2212x1659 — 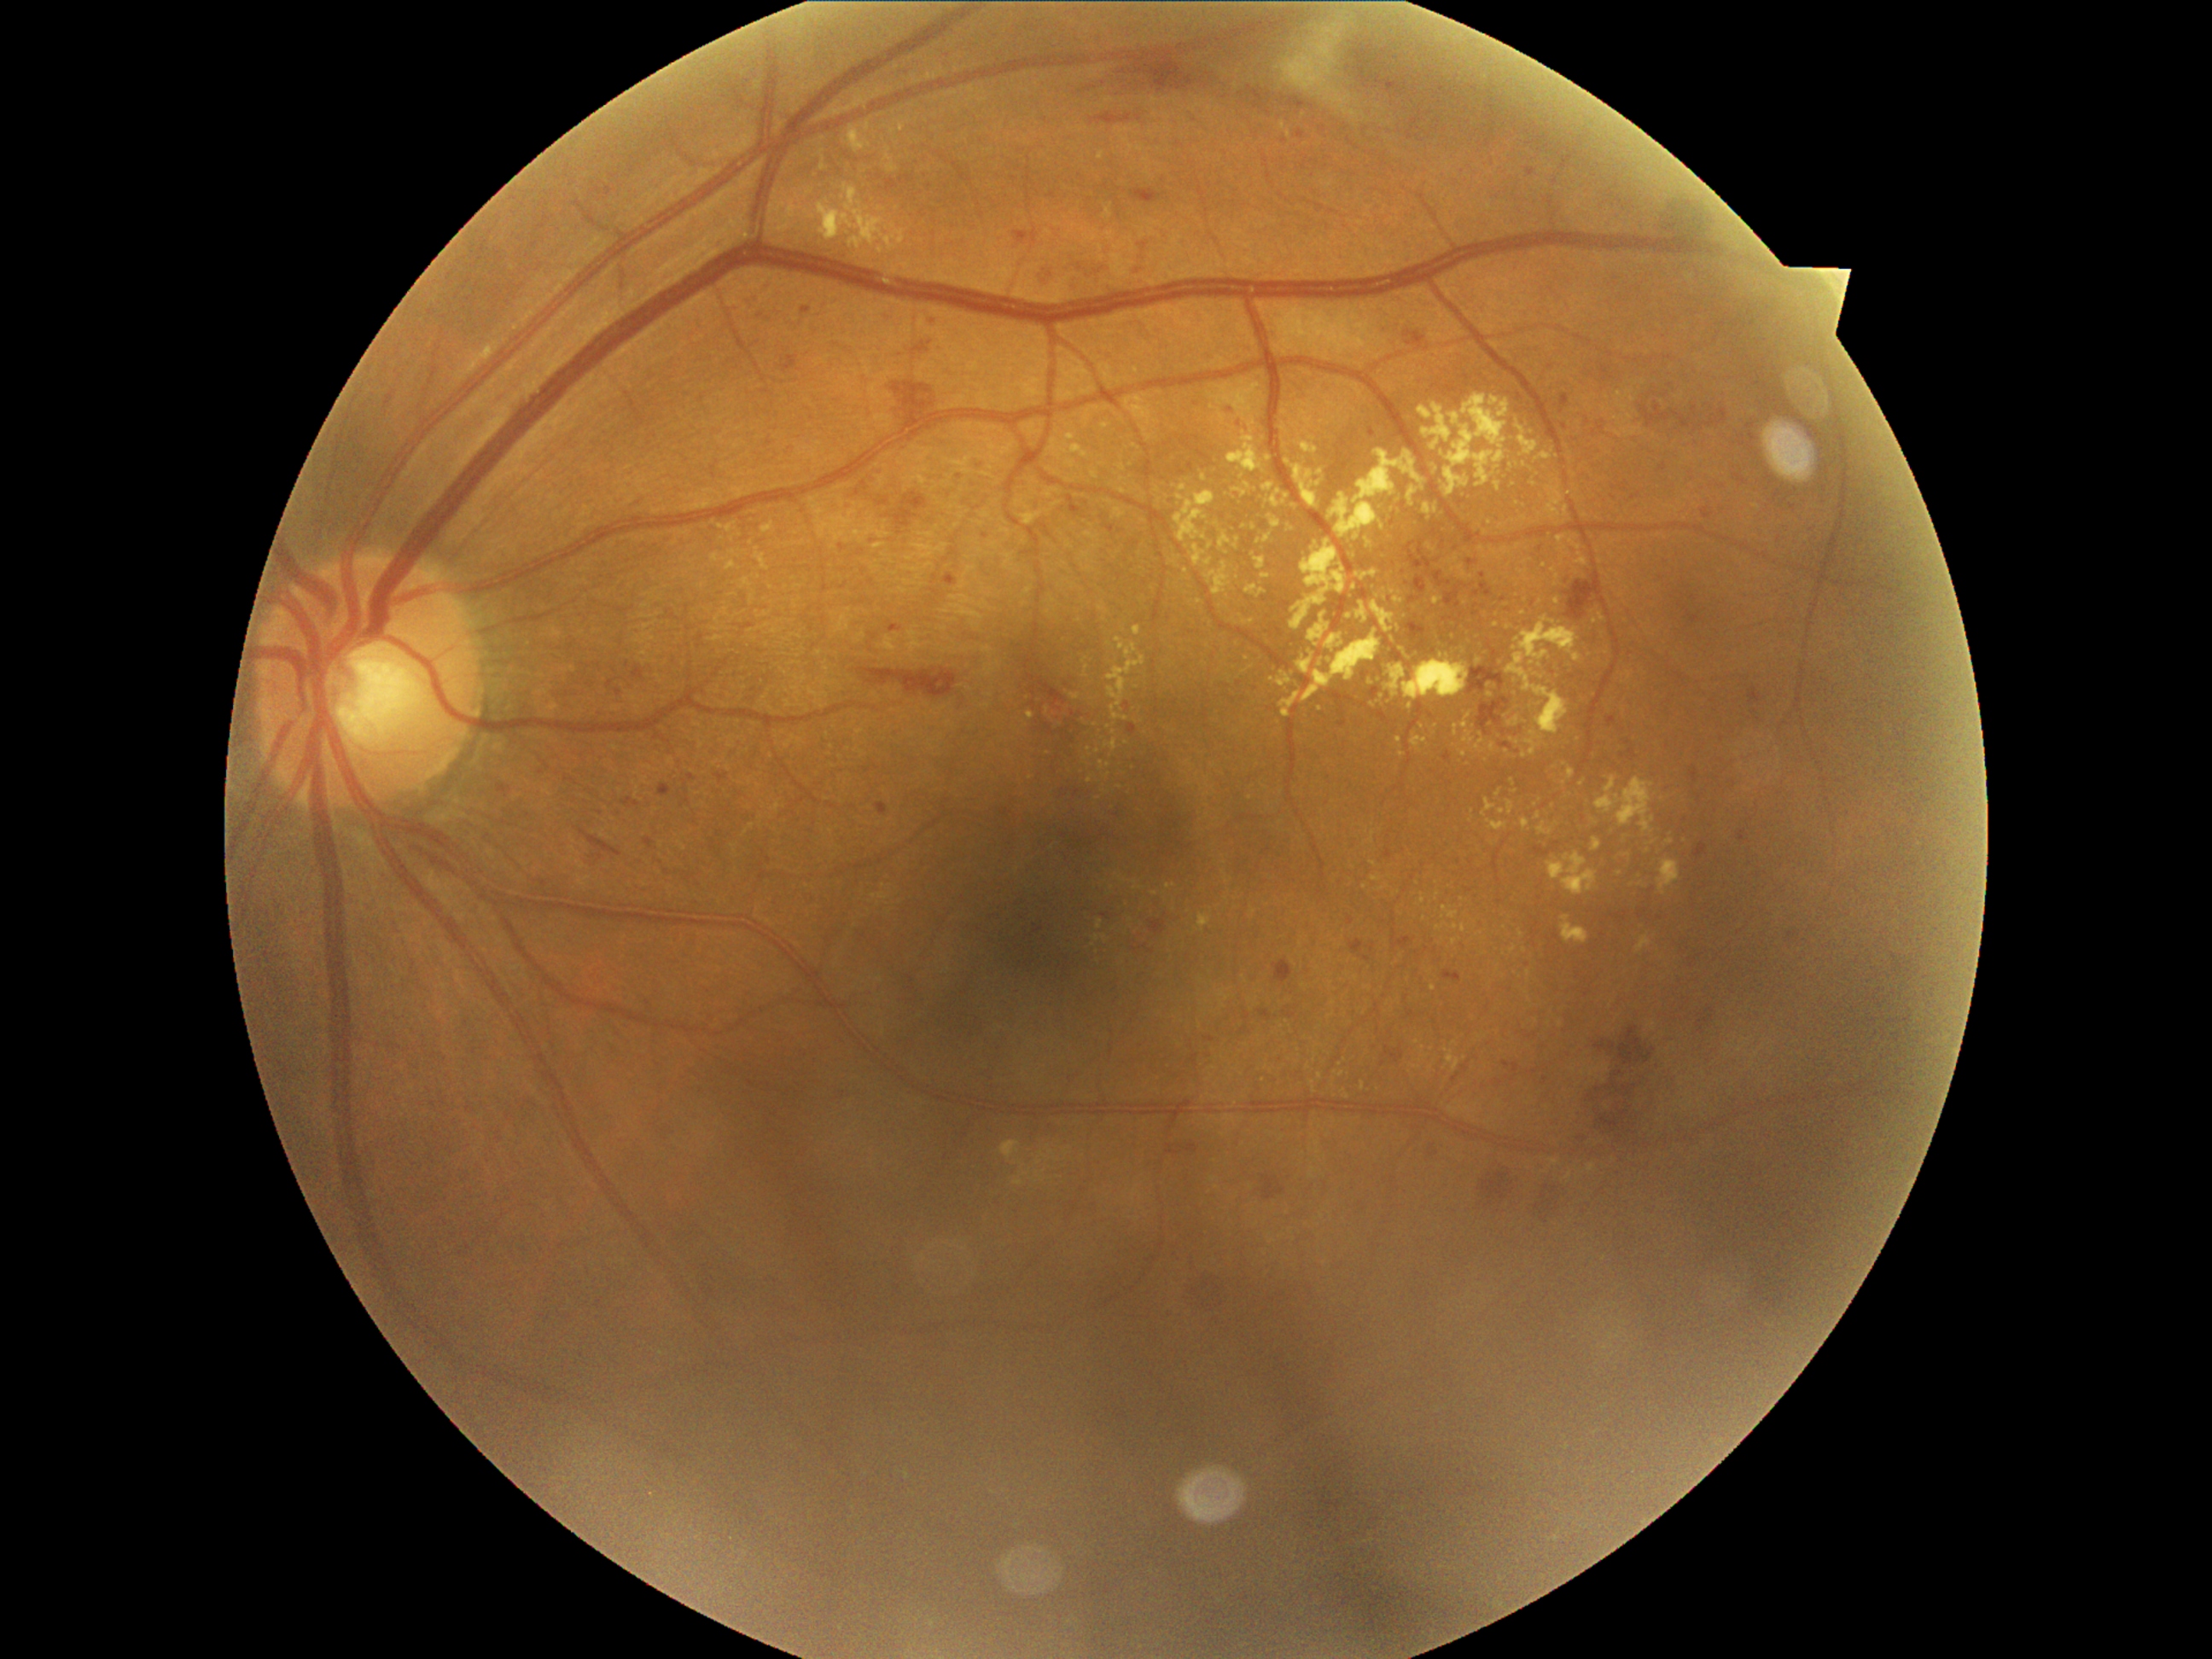 Retinopathy grade is 2 (moderate NPDR)
Representative lesions:
hard exudates (continued): rect(1433, 598, 1443, 607) | rect(1395, 736, 1402, 745) | rect(1385, 665, 1407, 697) | rect(1289, 521, 1298, 533) | rect(1464, 721, 1476, 747) | rect(1638, 936, 1651, 953) | rect(1069, 694, 1080, 701) | rect(1240, 615, 1255, 627) | rect(1105, 637, 1148, 721)
Smaller hard exudates around <pt>1417,1067</pt> | <pt>1434,989</pt> | <pt>1309,1066</pt> | <pt>1112,663</pt> | <pt>1496,626</pt> | <pt>1283,127</pt> | <pt>1540,604</pt> | <pt>1647,850</pt> | <pt>1521,934</pt> | <pt>1392,506</pt>